1240x1240 · wide-field fundus photograph from neonatal ROP screening · 100° field of view (Phoenix ICON).
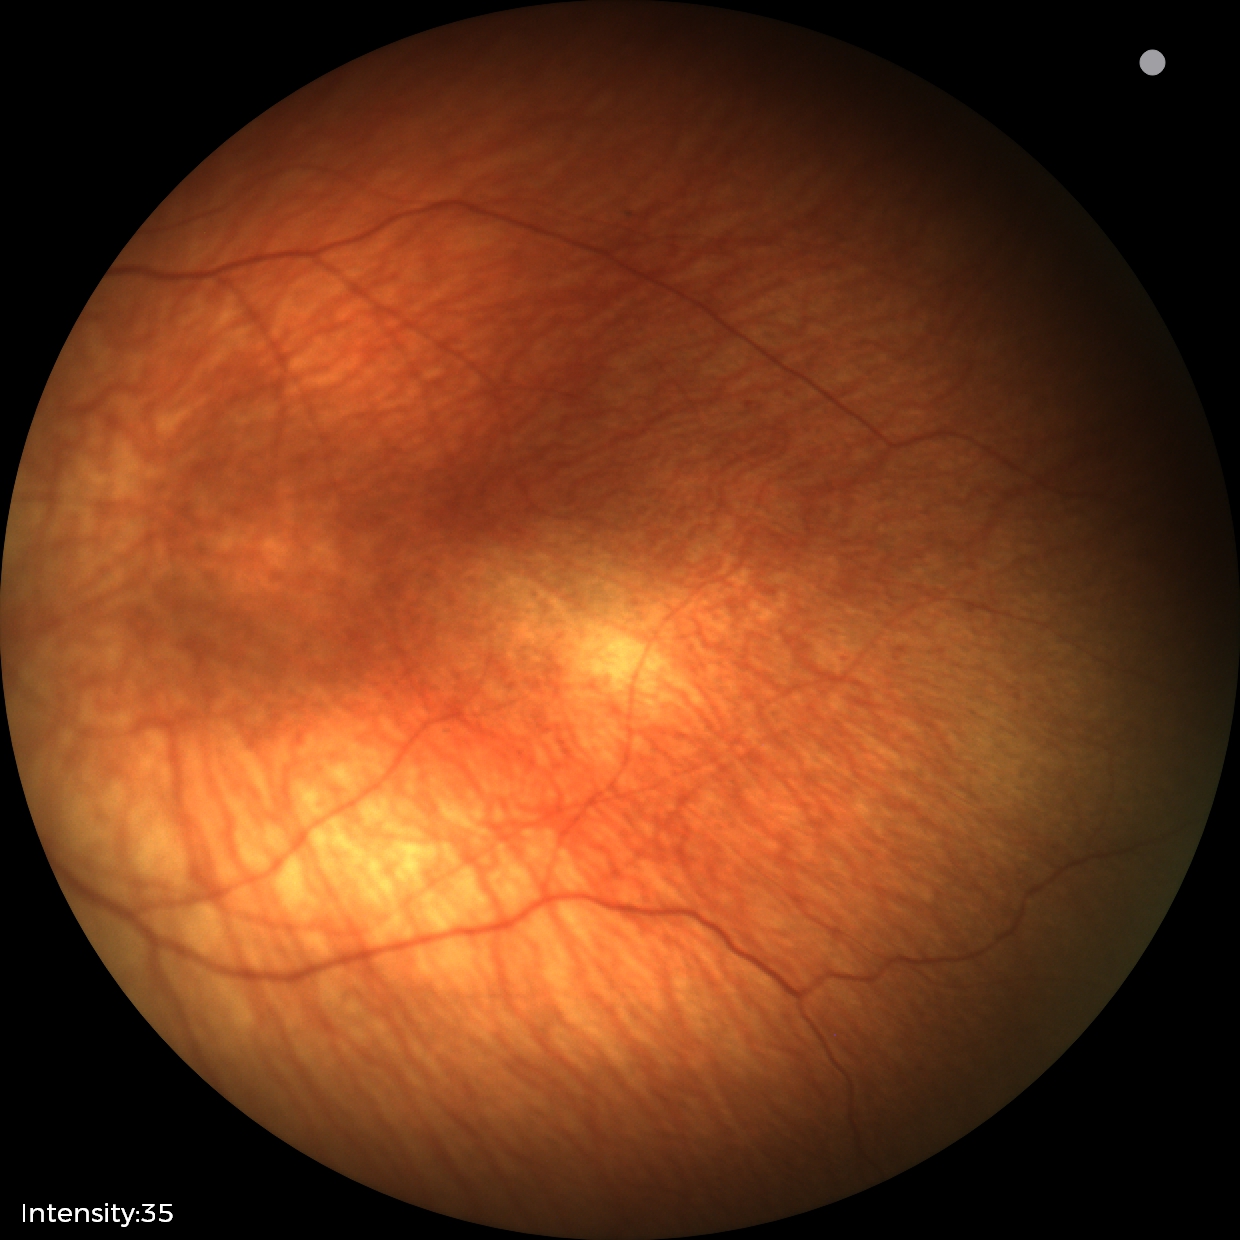

Diagnosis from this screening exam: status post ROP.
No plus disease.